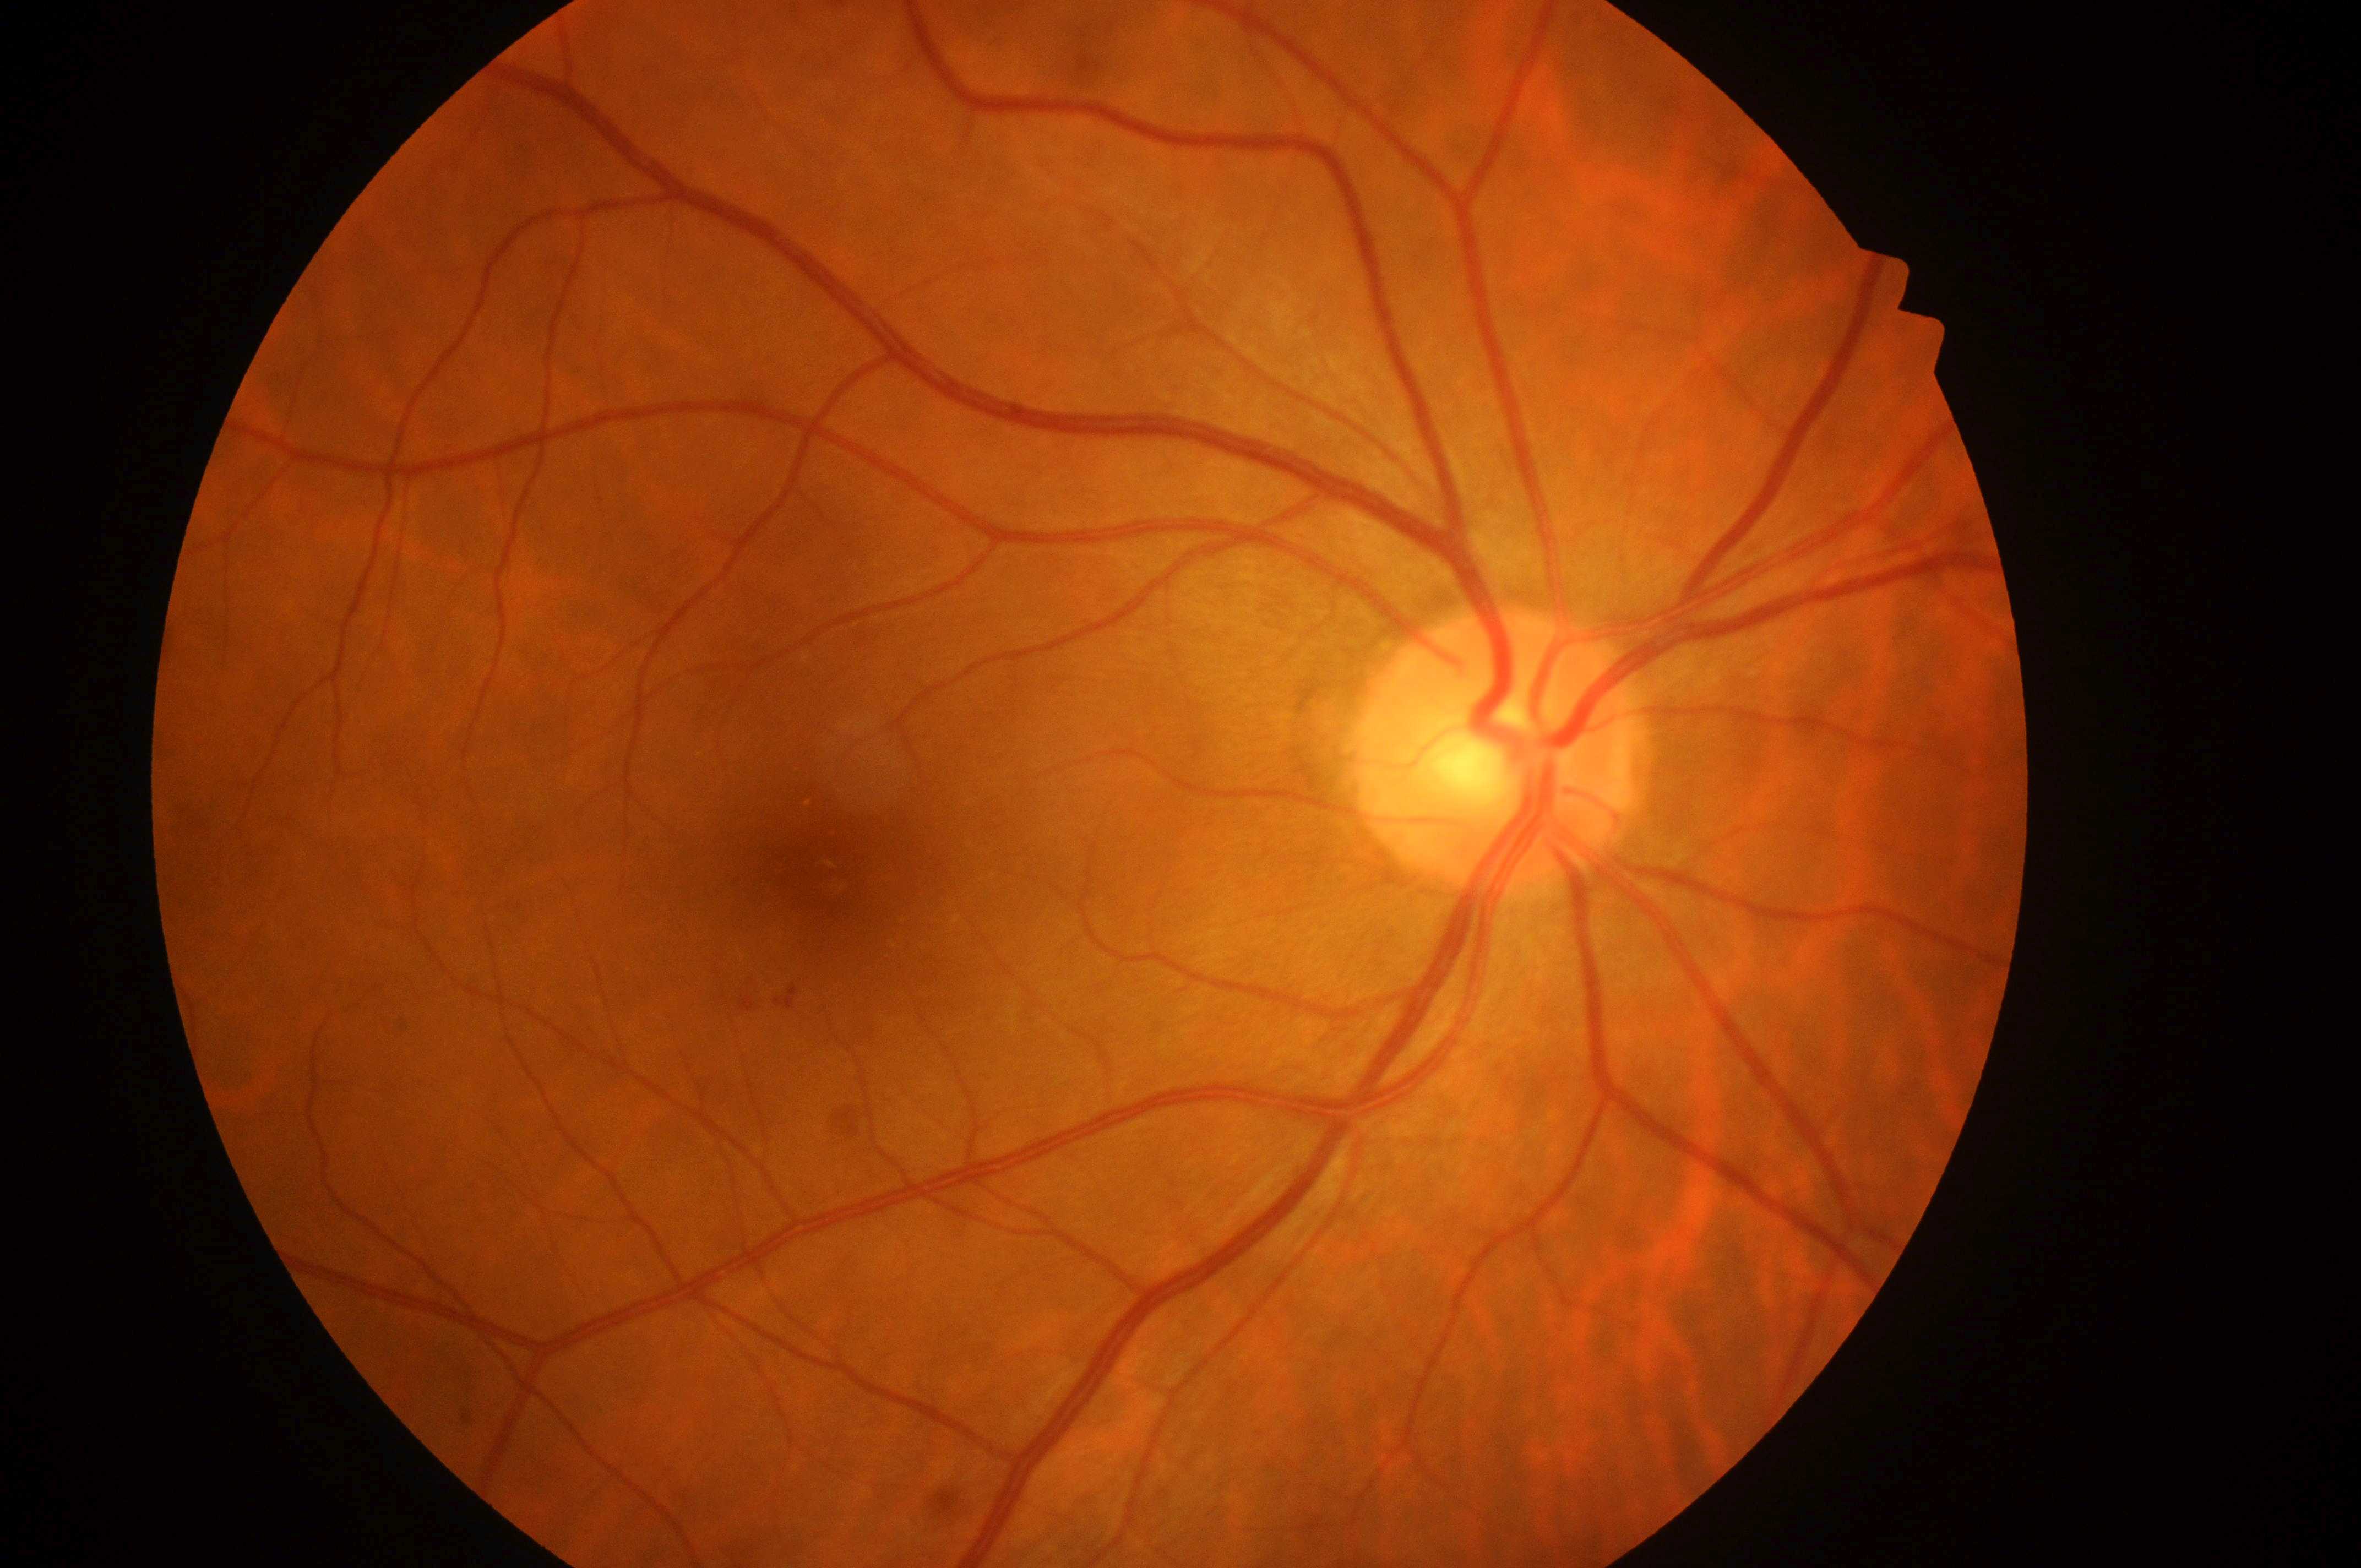

Diabetic retinopathy grade: moderate NPDR (2) — more than just microaneurysms but less than severe NPDR.
Disc center located at [1491, 760].
The macular center is at [833, 872].
Macular edema is grade 2 (high risk) — hard exudates within one disc diameter of the macula center.
Imaged eye: the right eye.